2212 by 1661 pixels. Refractive error: +2 -0.25 × 135°. Intraocular pressure: 15 mmHg:
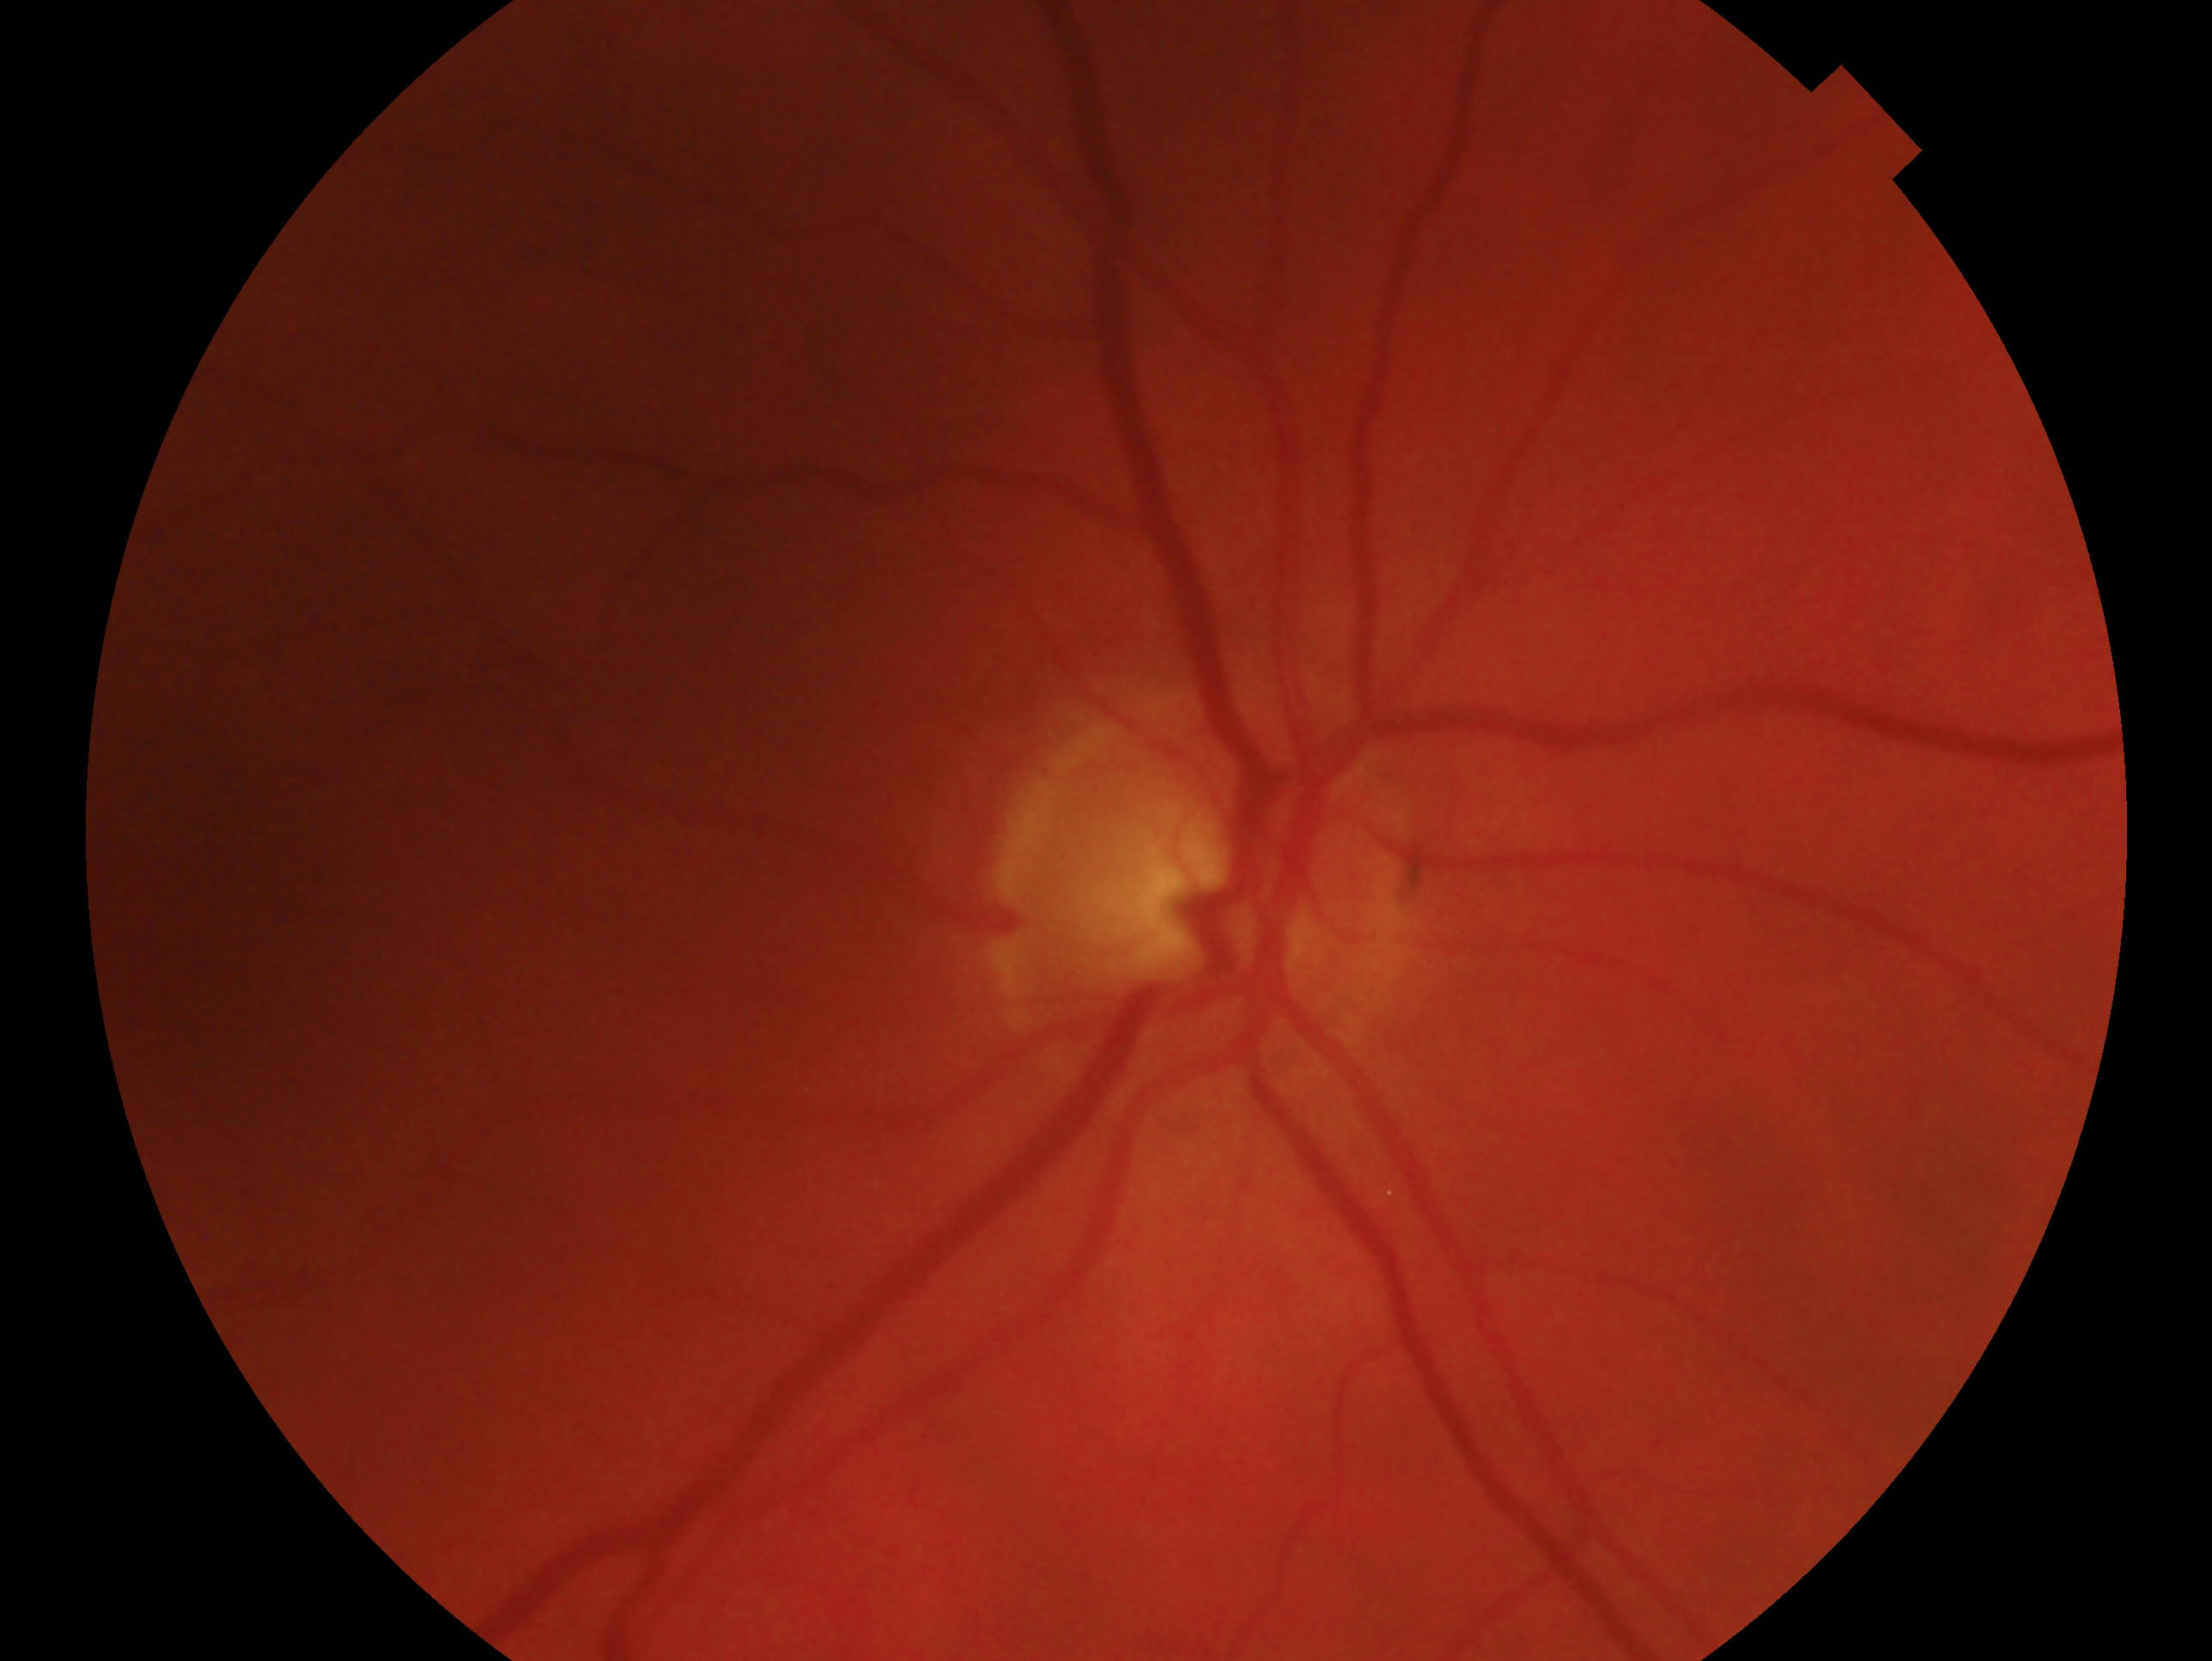

Q: Glaucoma classification?
A: suspicious for glaucoma
Q: What is the laterality?
A: right